No pharmacologic dilation:
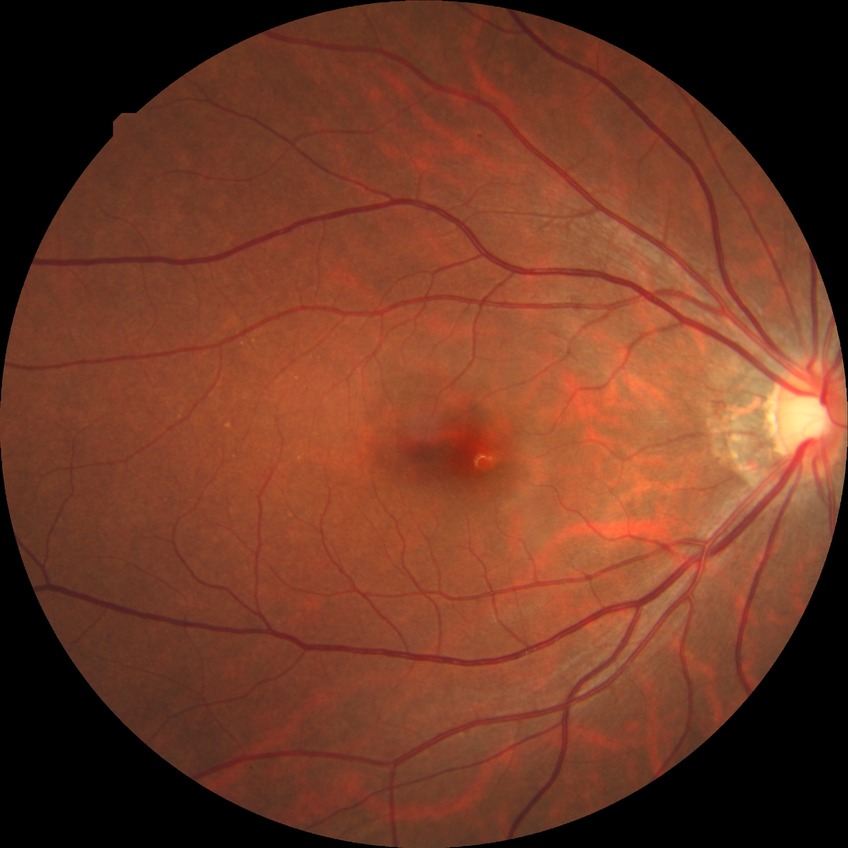

DR: NDR.